512x512px
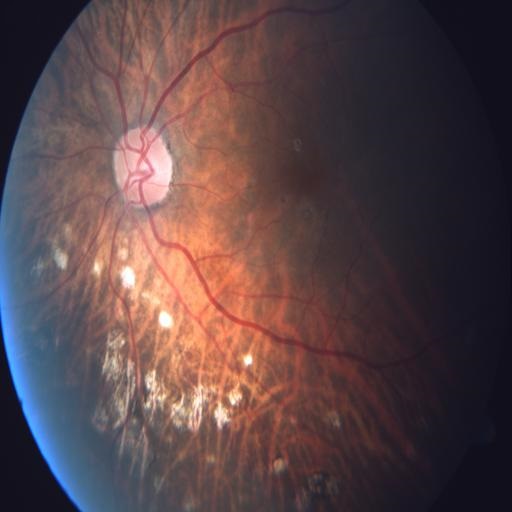

Three findings. Retinal fundus photograph demonstrating tessellation (TSLN), retinal pigment epithelium changes (RPEC) & myopia (MYA).